Fundus photo. 45° field of view — 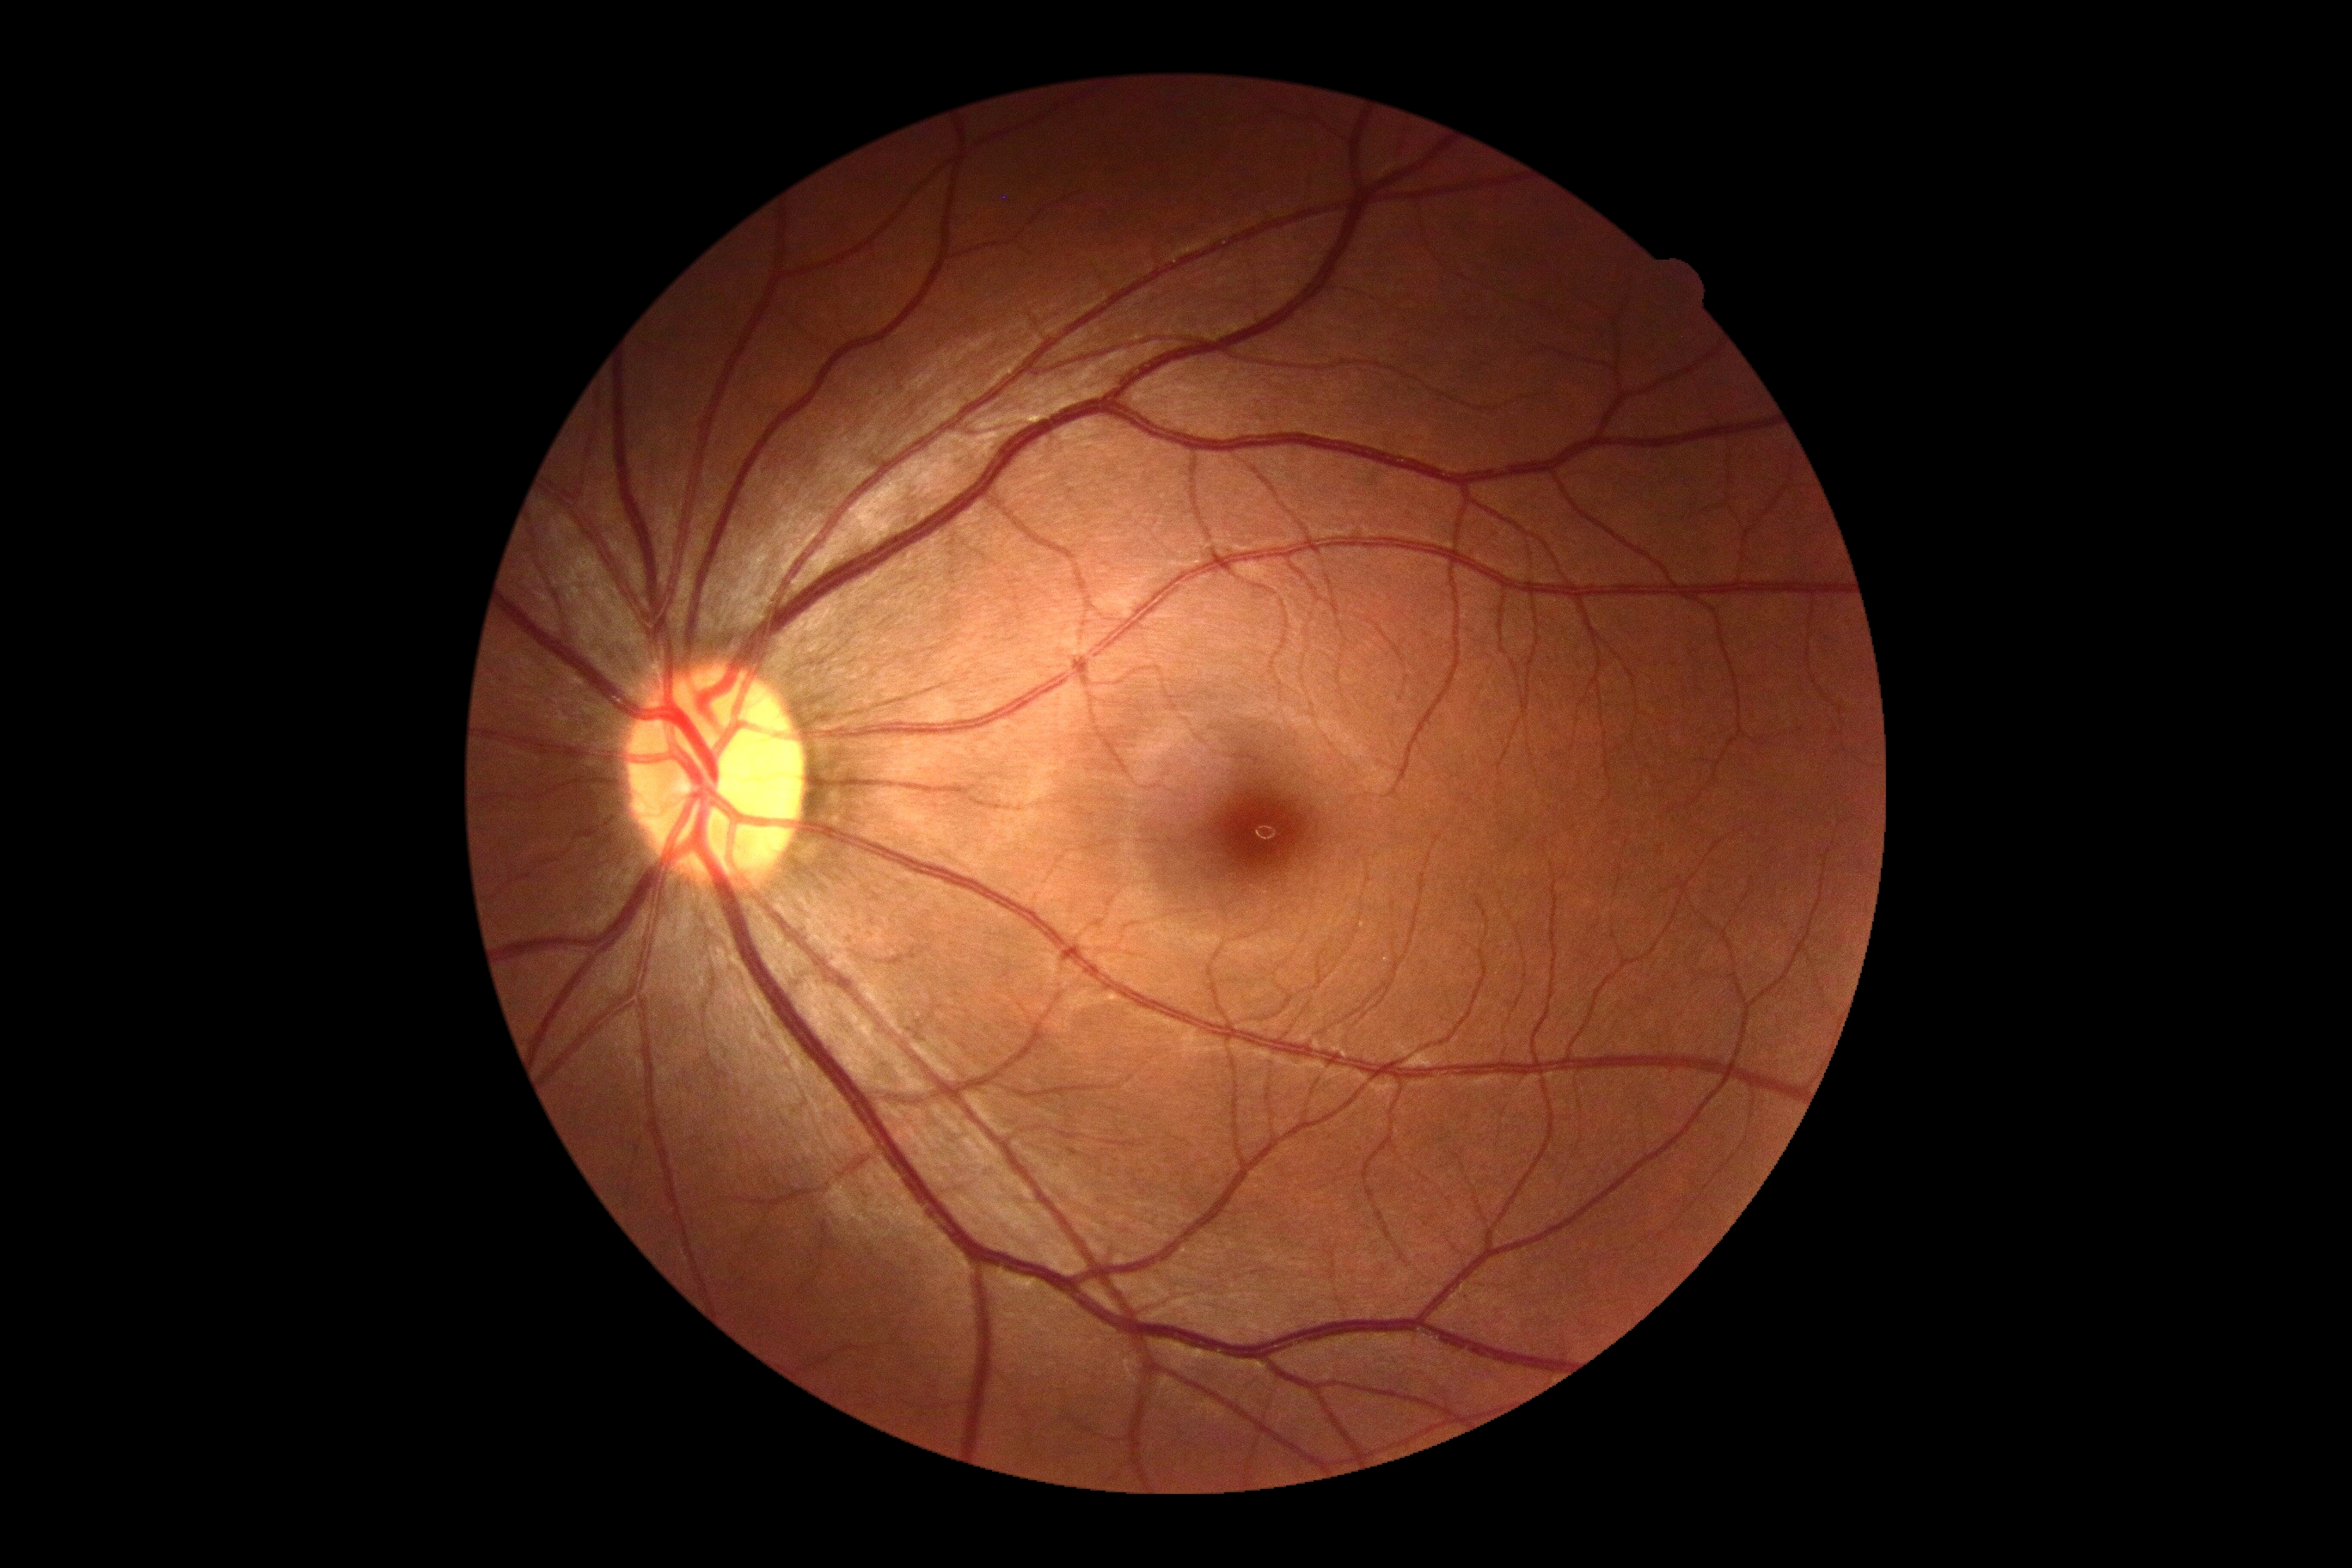 Diabetic retinopathy grade is 0 (no apparent retinopathy).